Graded on the modified Davis scale, image size 848x848, NIDEK AFC-230 — 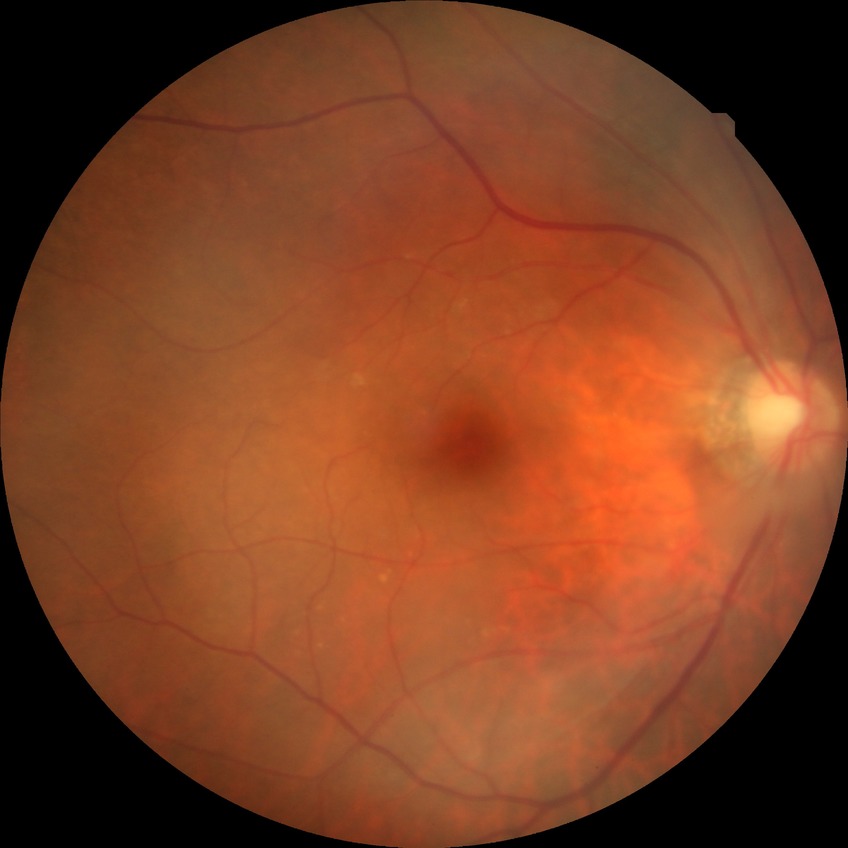
Diabetic retinopathy (DR) is NDR (no diabetic retinopathy).